1240 by 1240 pixels; pediatric wide-field fundus photograph: 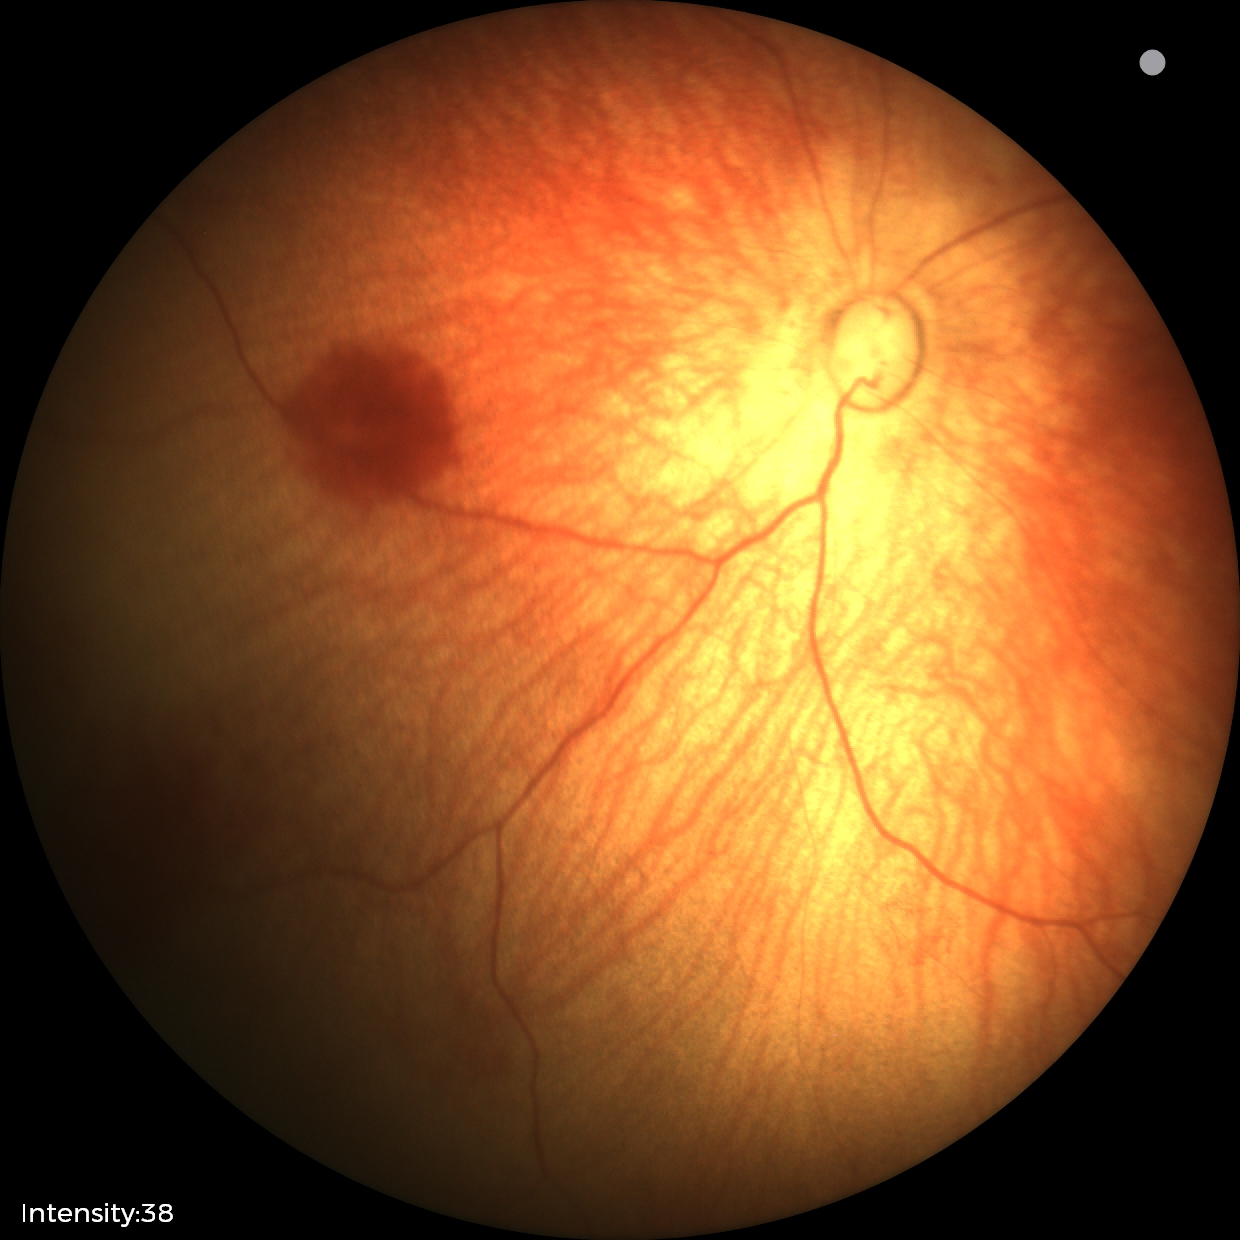
Screening diagnosis: normal retinal appearance.